2184x1690px — 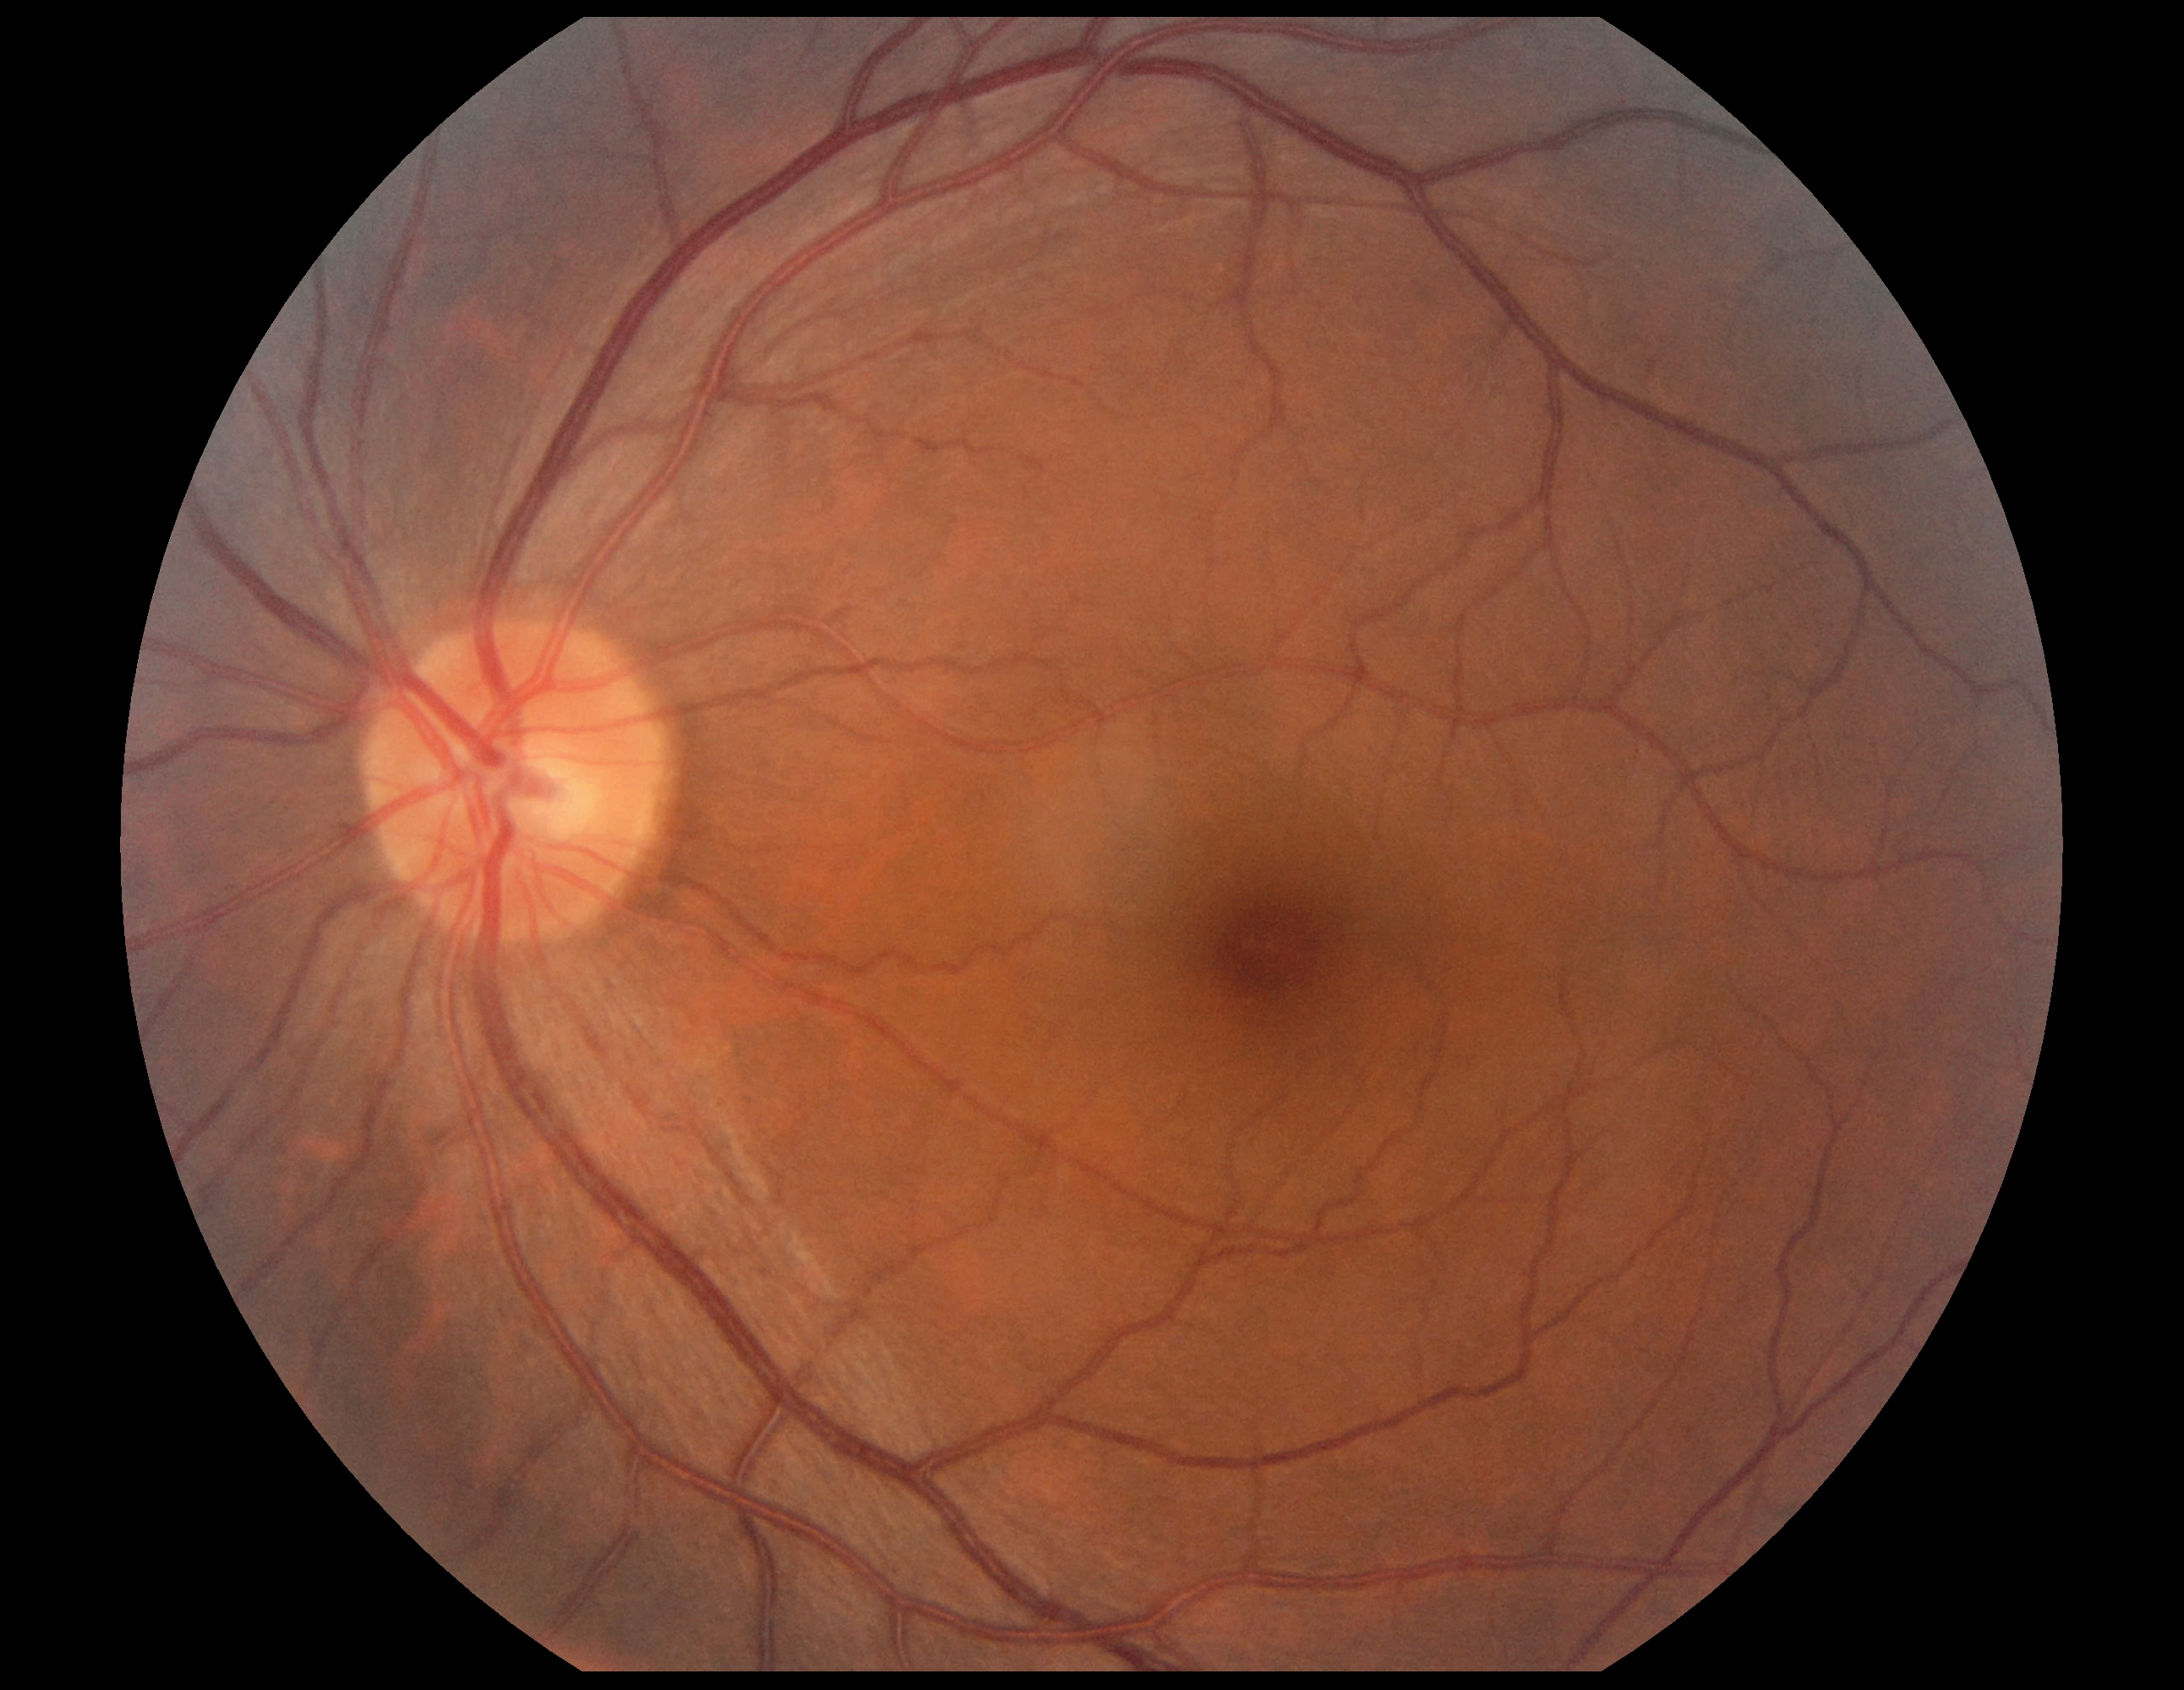

diabetic retinopathy grade = 0.